CFP.
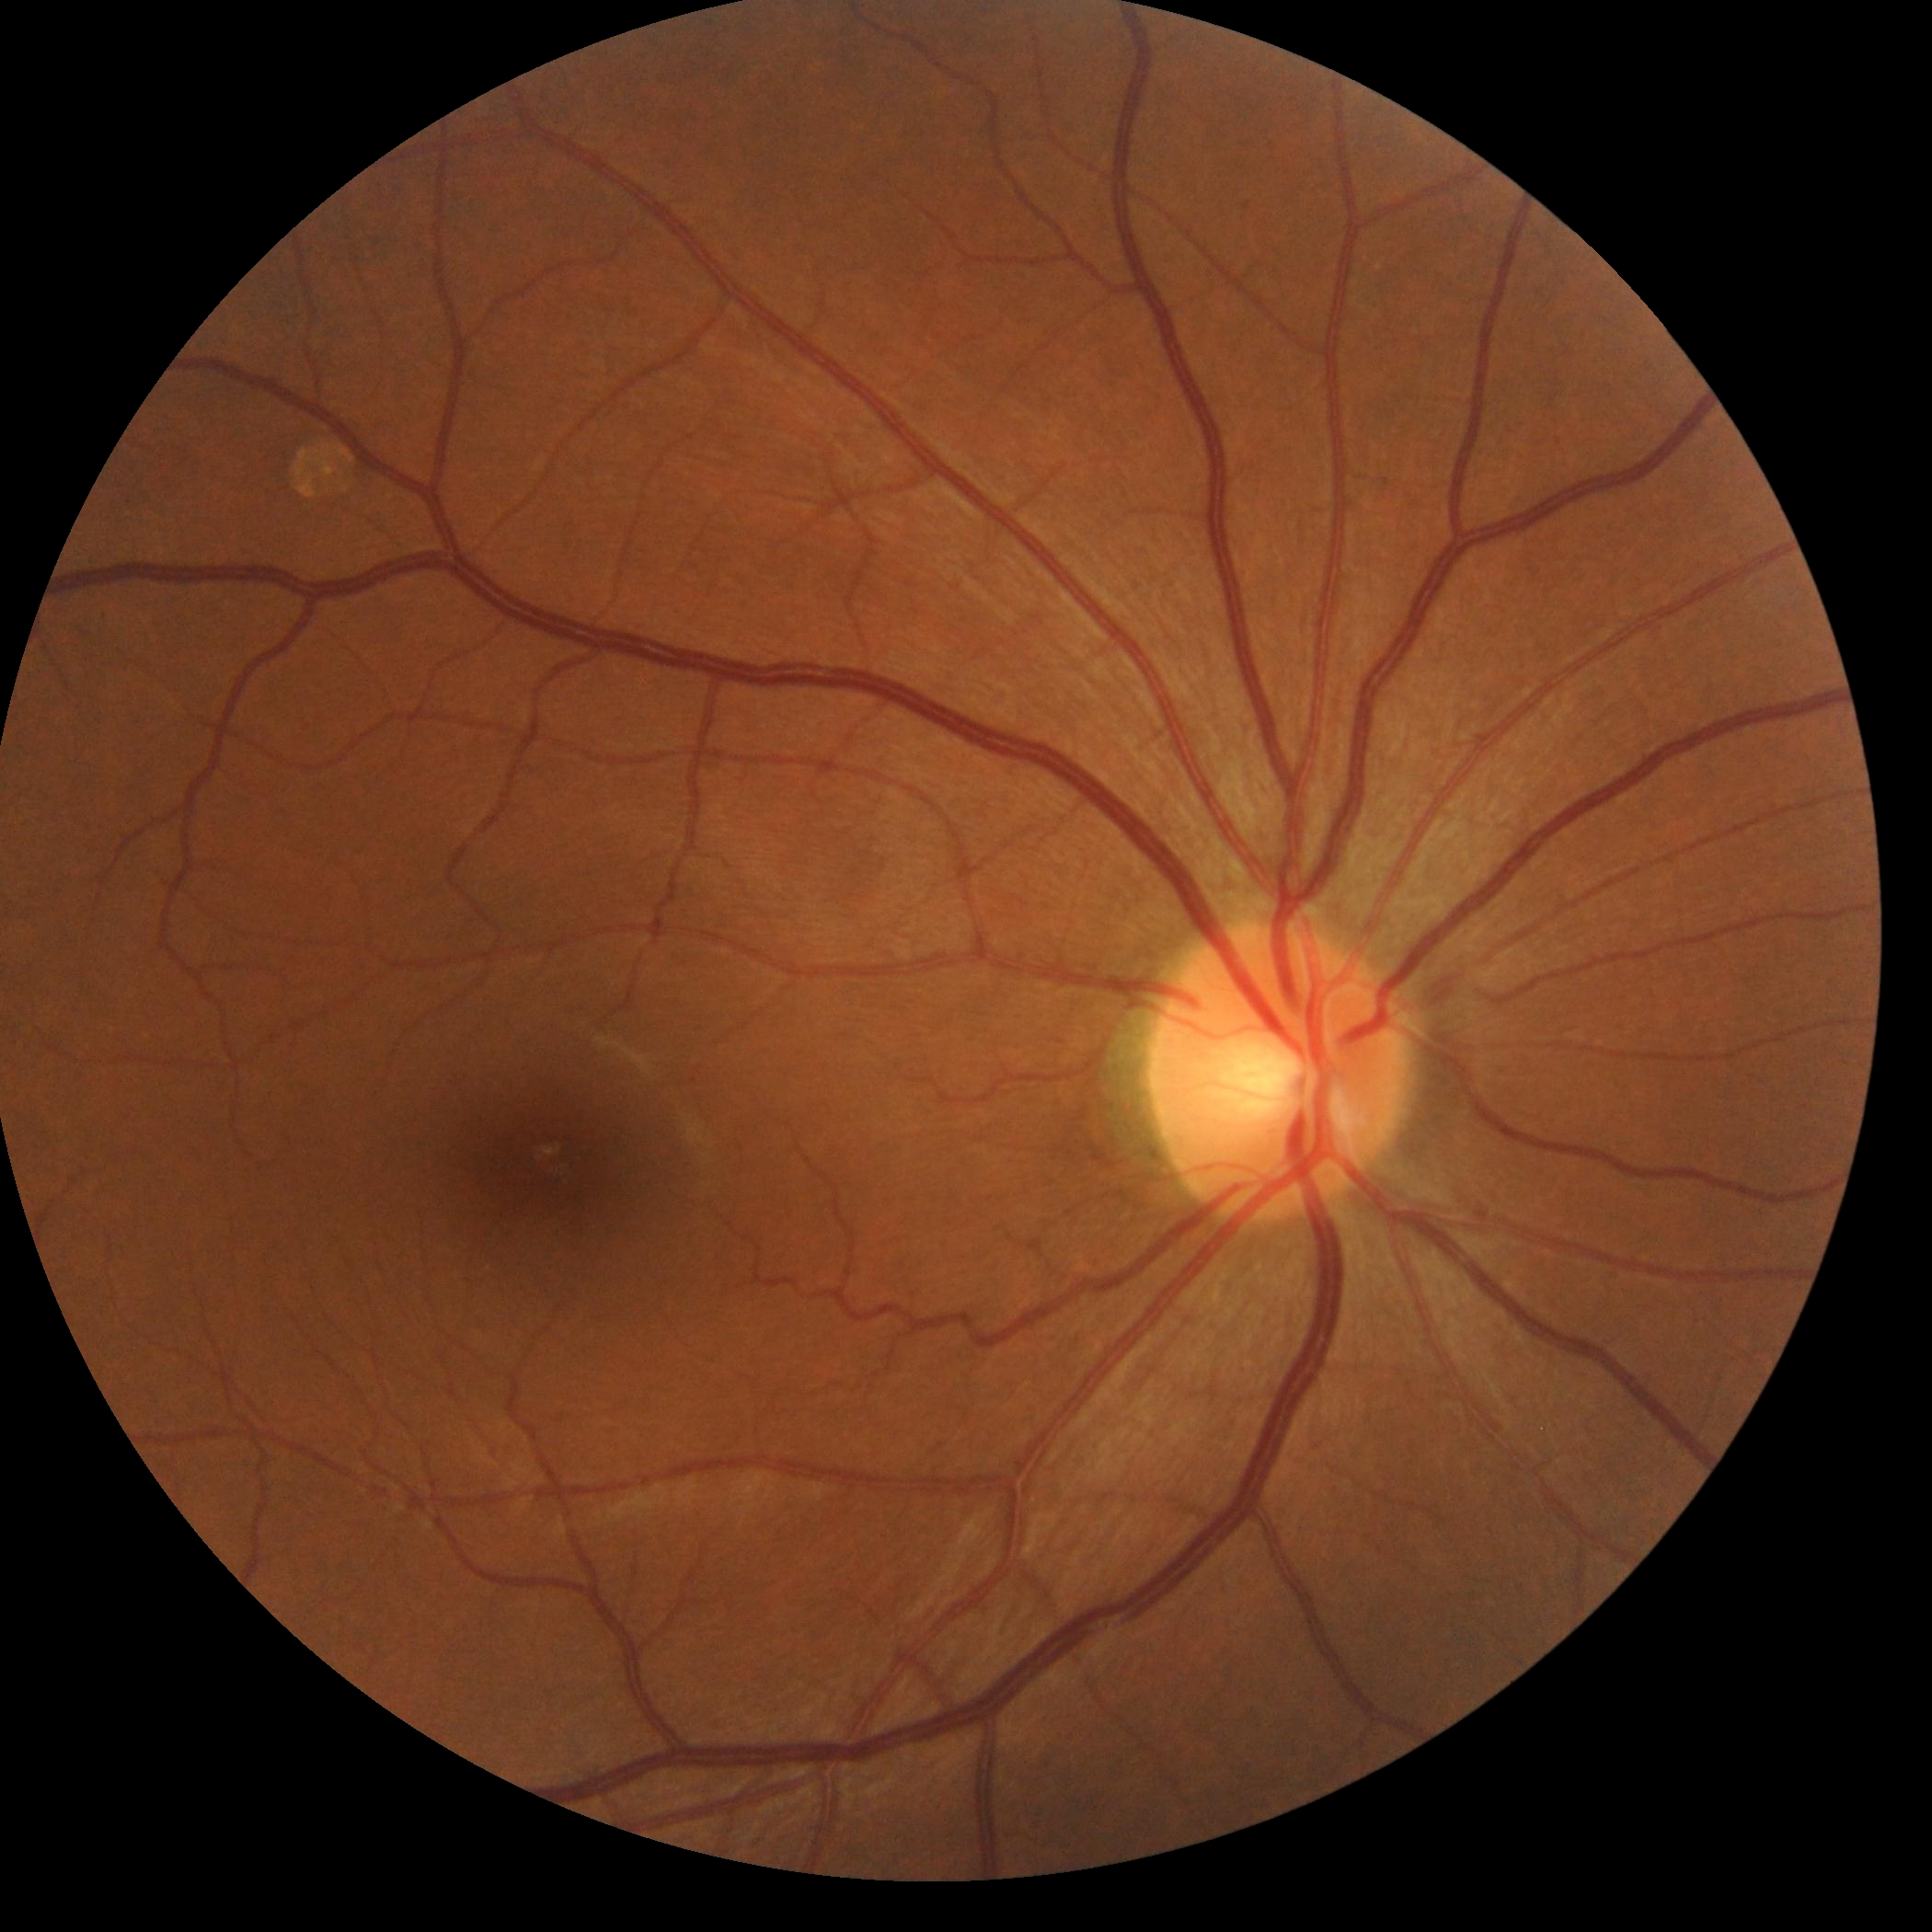

Diabetic retinopathy (DR): 0. No apparent diabetic retinopathy.